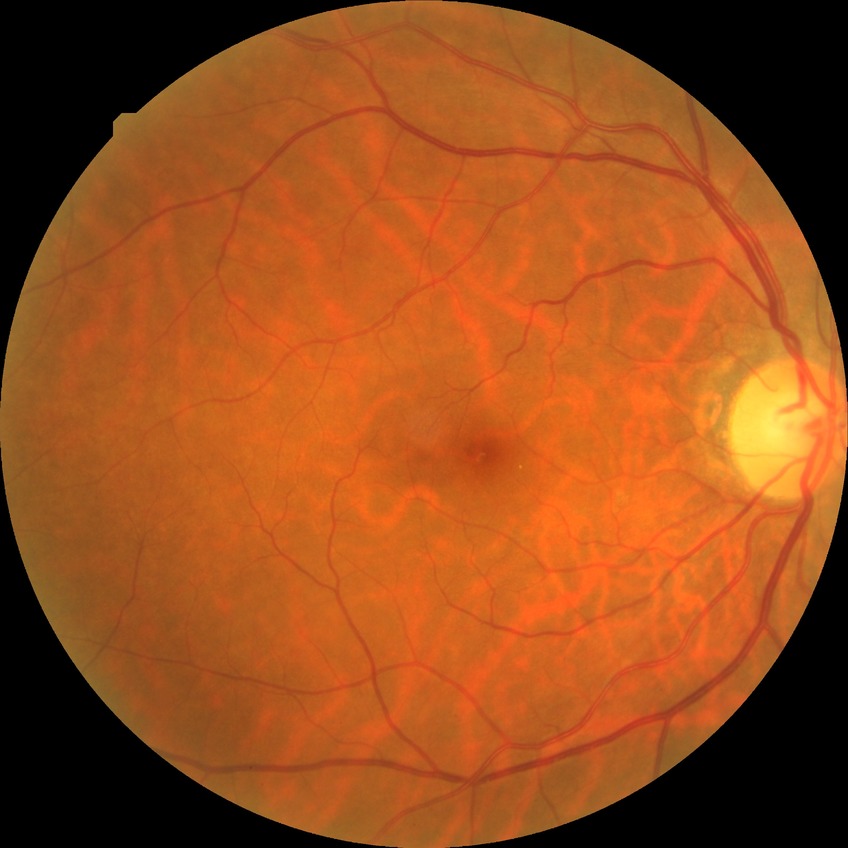

Findings:
• modified Davis grading: no diabetic retinopathy